640x480. Wide-field fundus photograph of an infant:
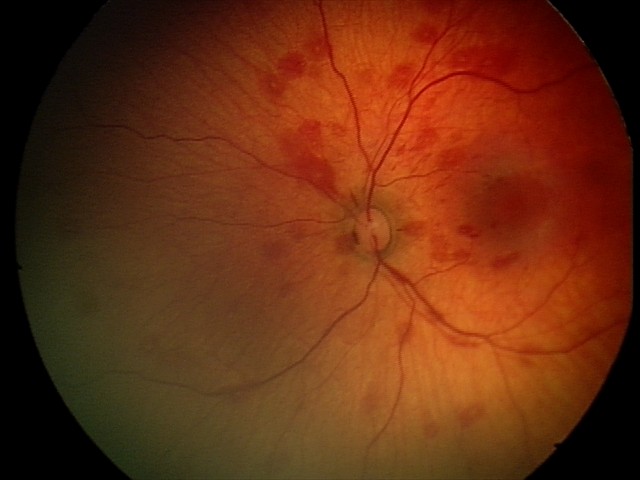

Finding = retinal hemorrhages.